Image size 848x848 — 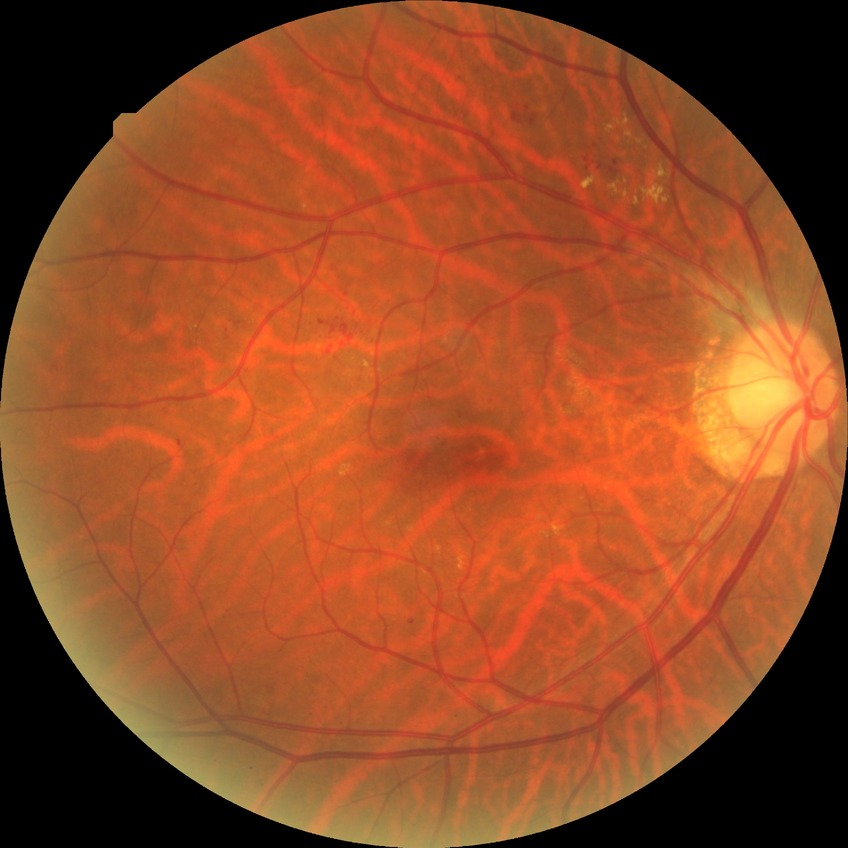 * DR class — non-proliferative diabetic retinopathy
* diabetic retinopathy (DR) — simple diabetic retinopathy (SDR)